Wide-field fundus image from infant ROP screening · 1440 x 1080 pixels
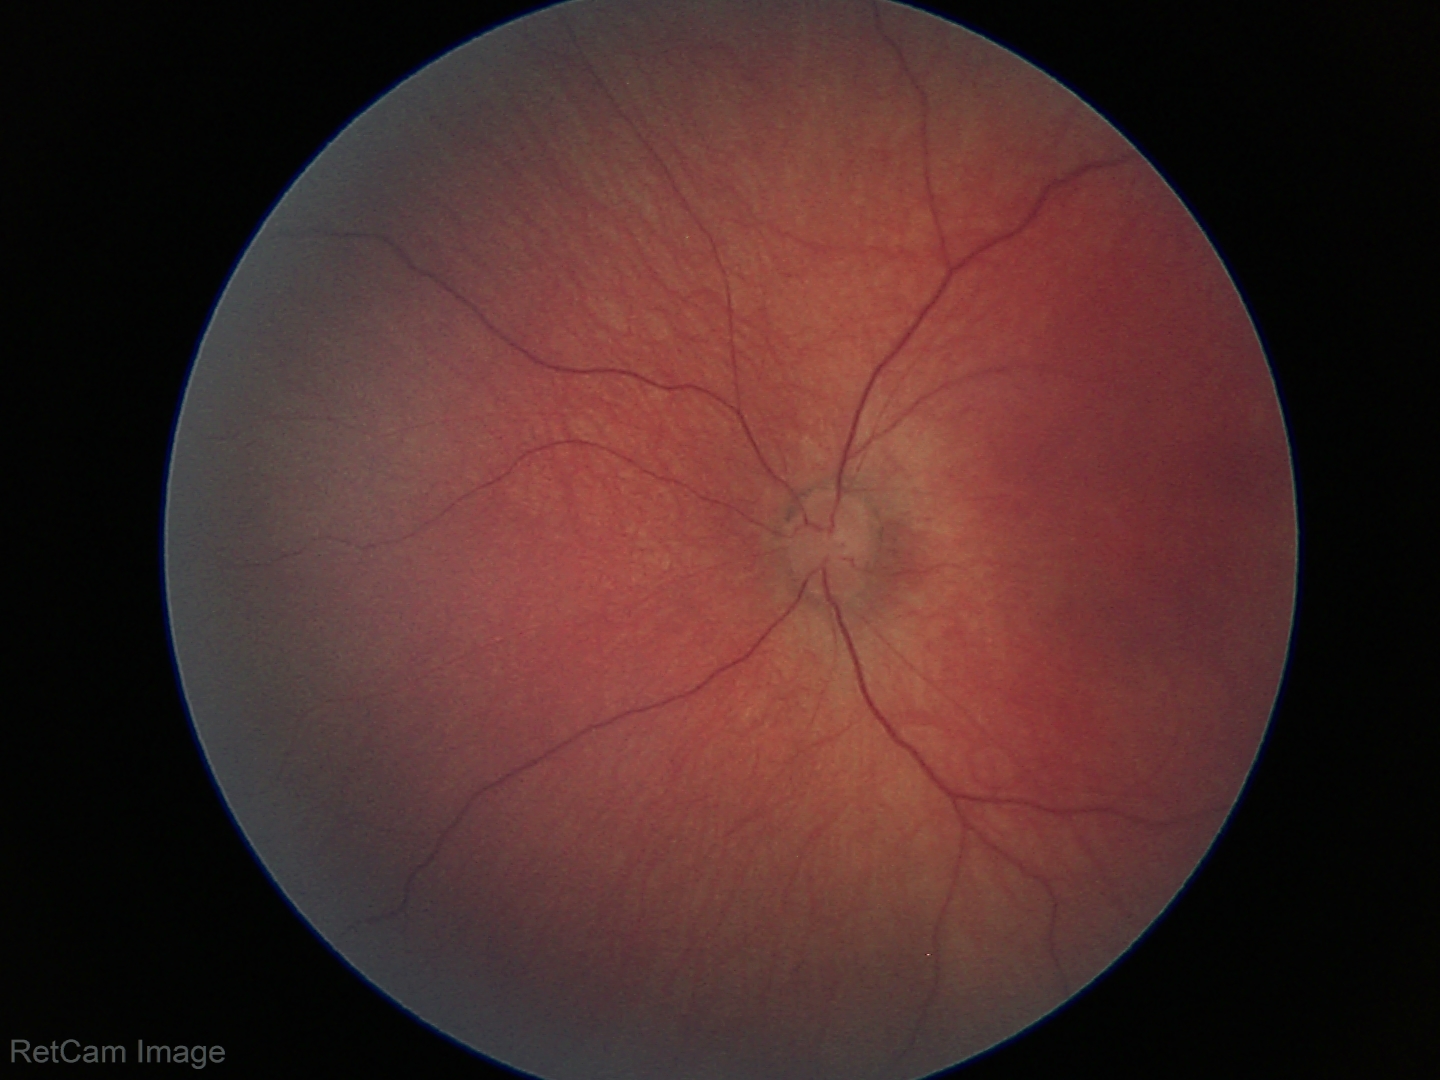

No retinal pathology identified on screening.